Diabetic retinopathy graded by the modified Davis classification · color fundus image: 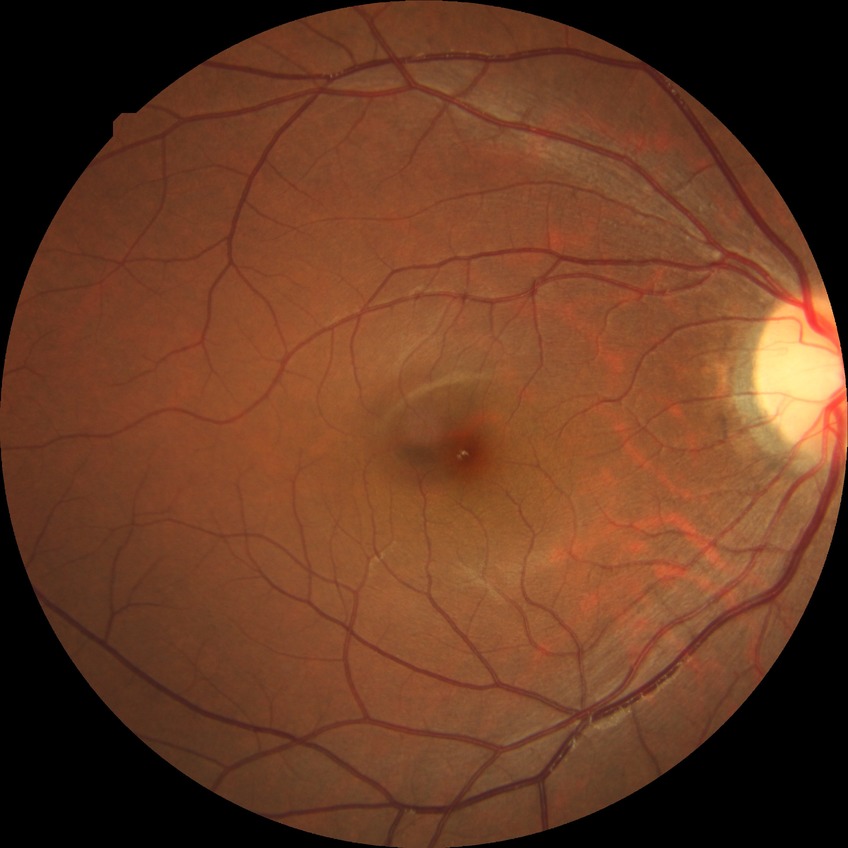

DR stage is NDR. No apparent diabetic retinopathy.